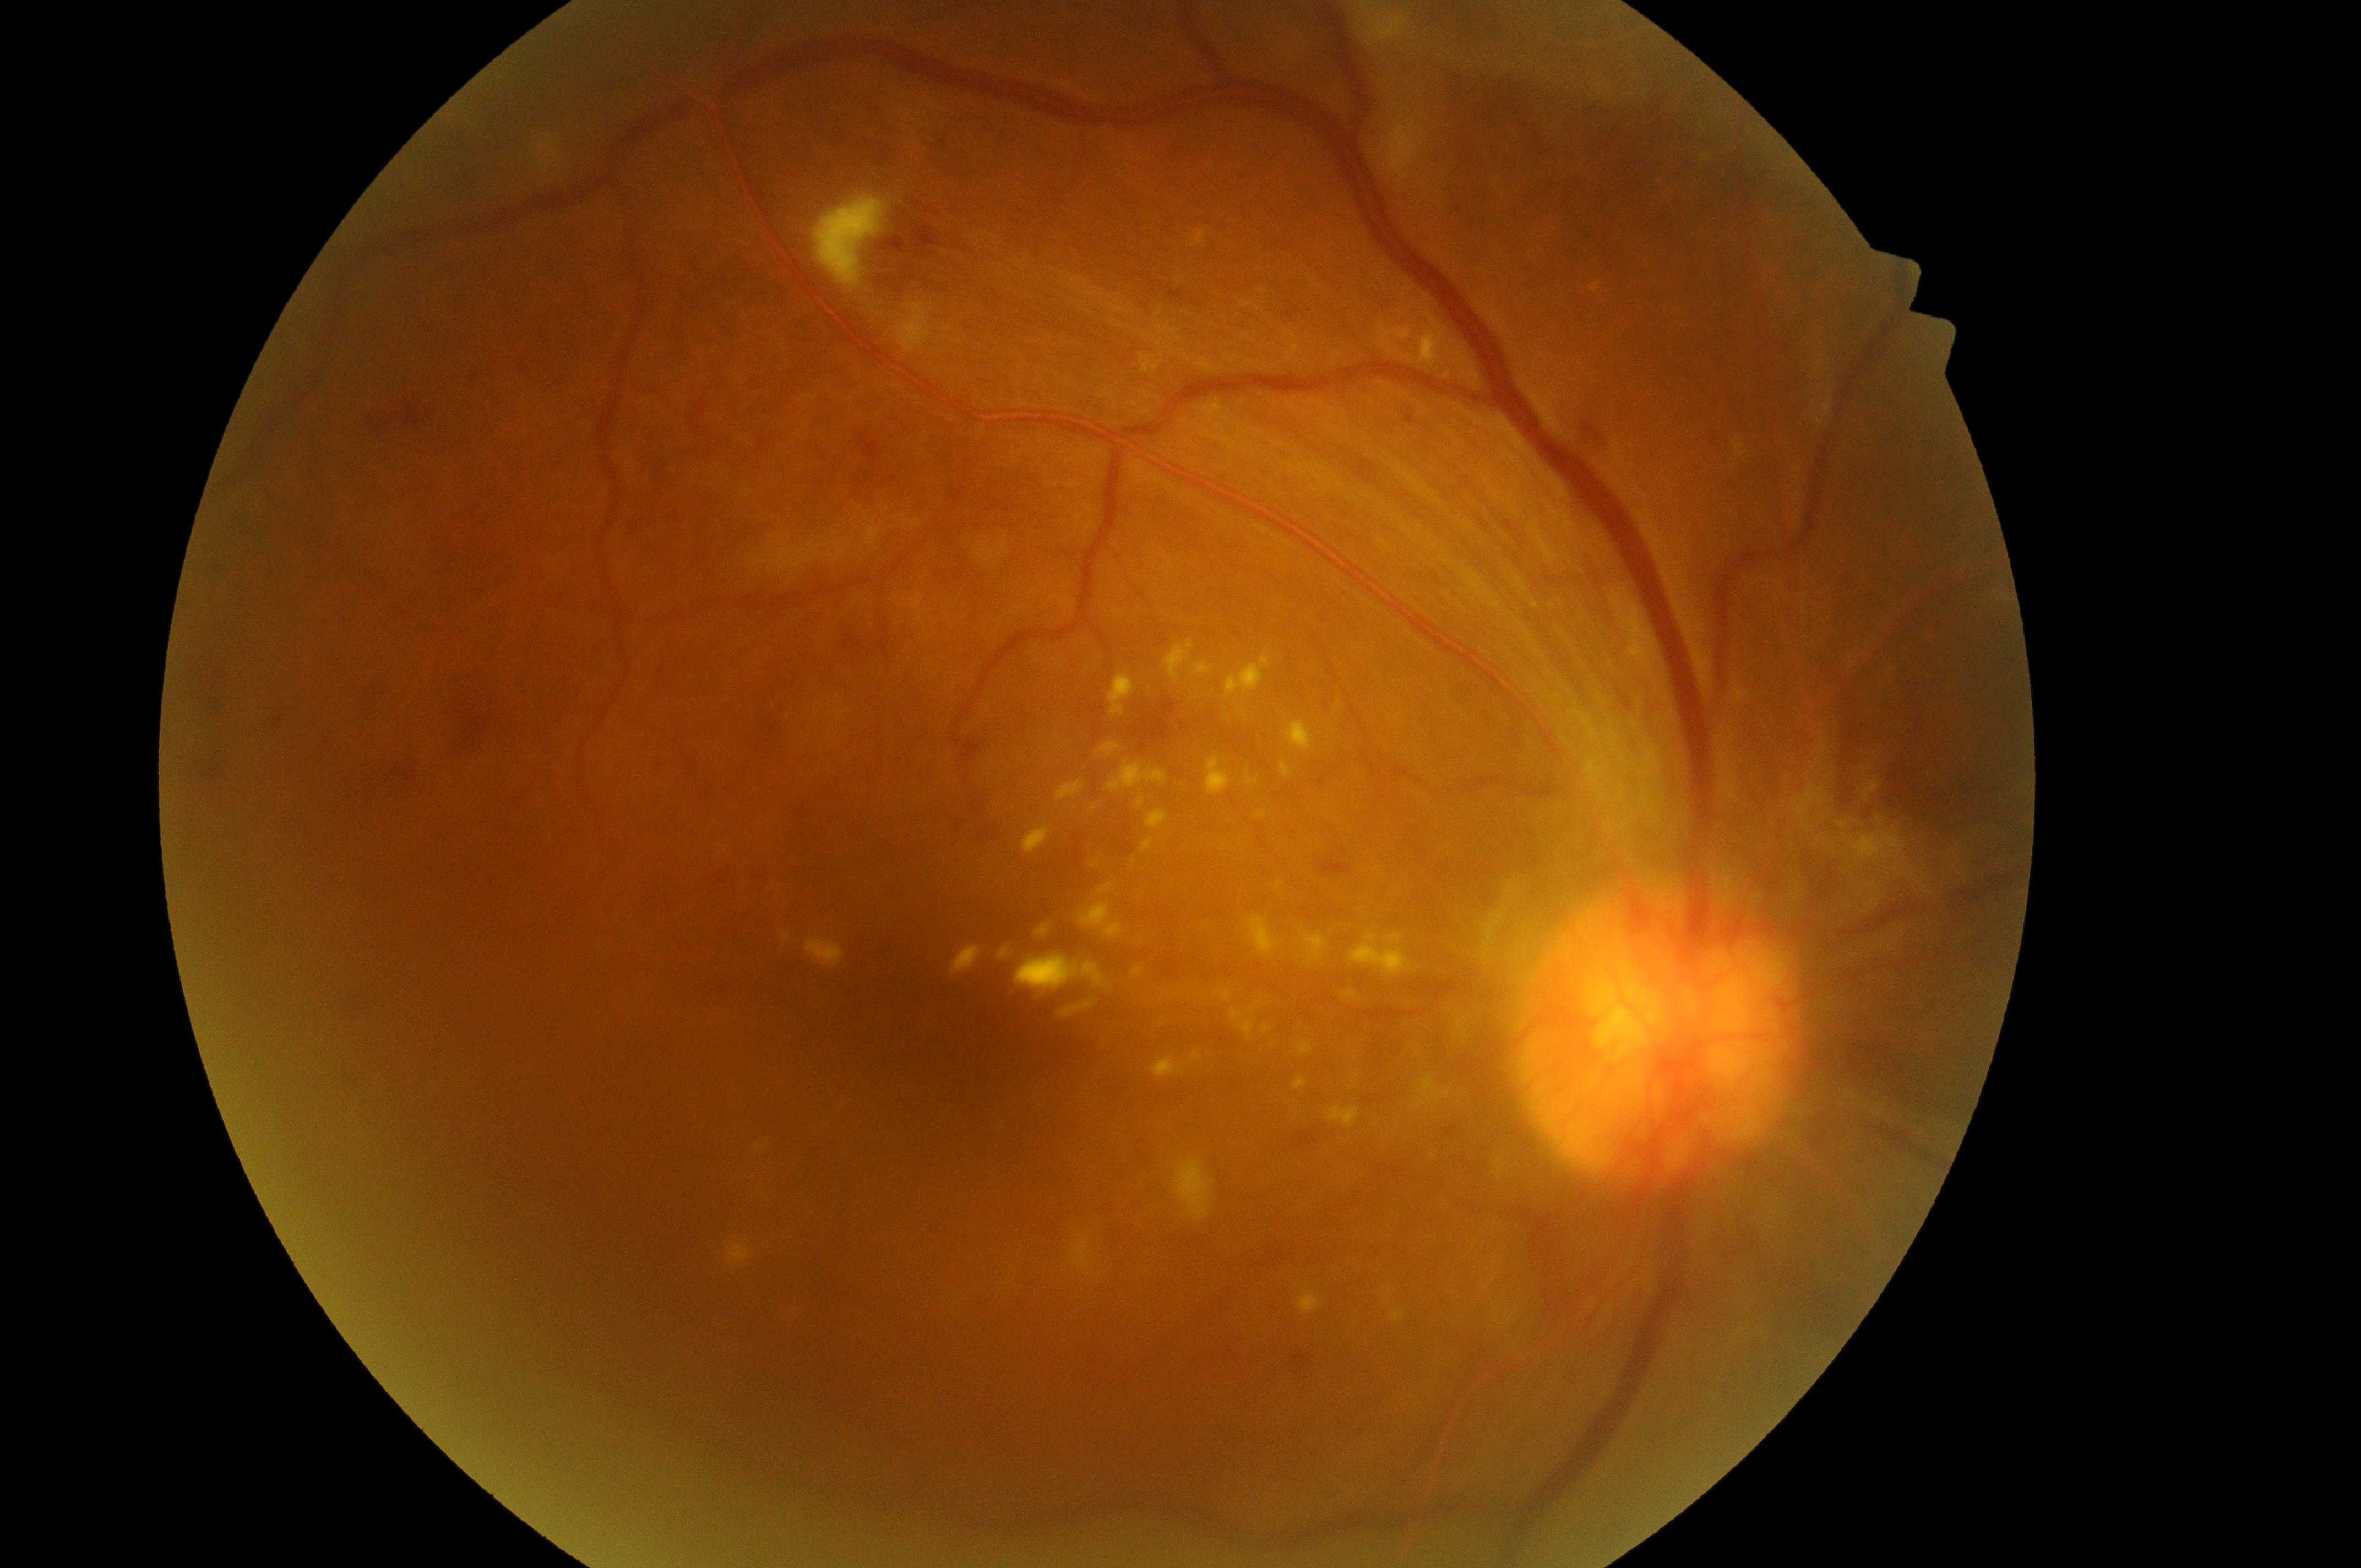

The fovea center is at x=955, y=1076. Retinopathy grade is 4/4. Optic disc located at x=1648, y=1064. Macular edema is 2. This is the right eye.